Fundus photo; 45° field of view:
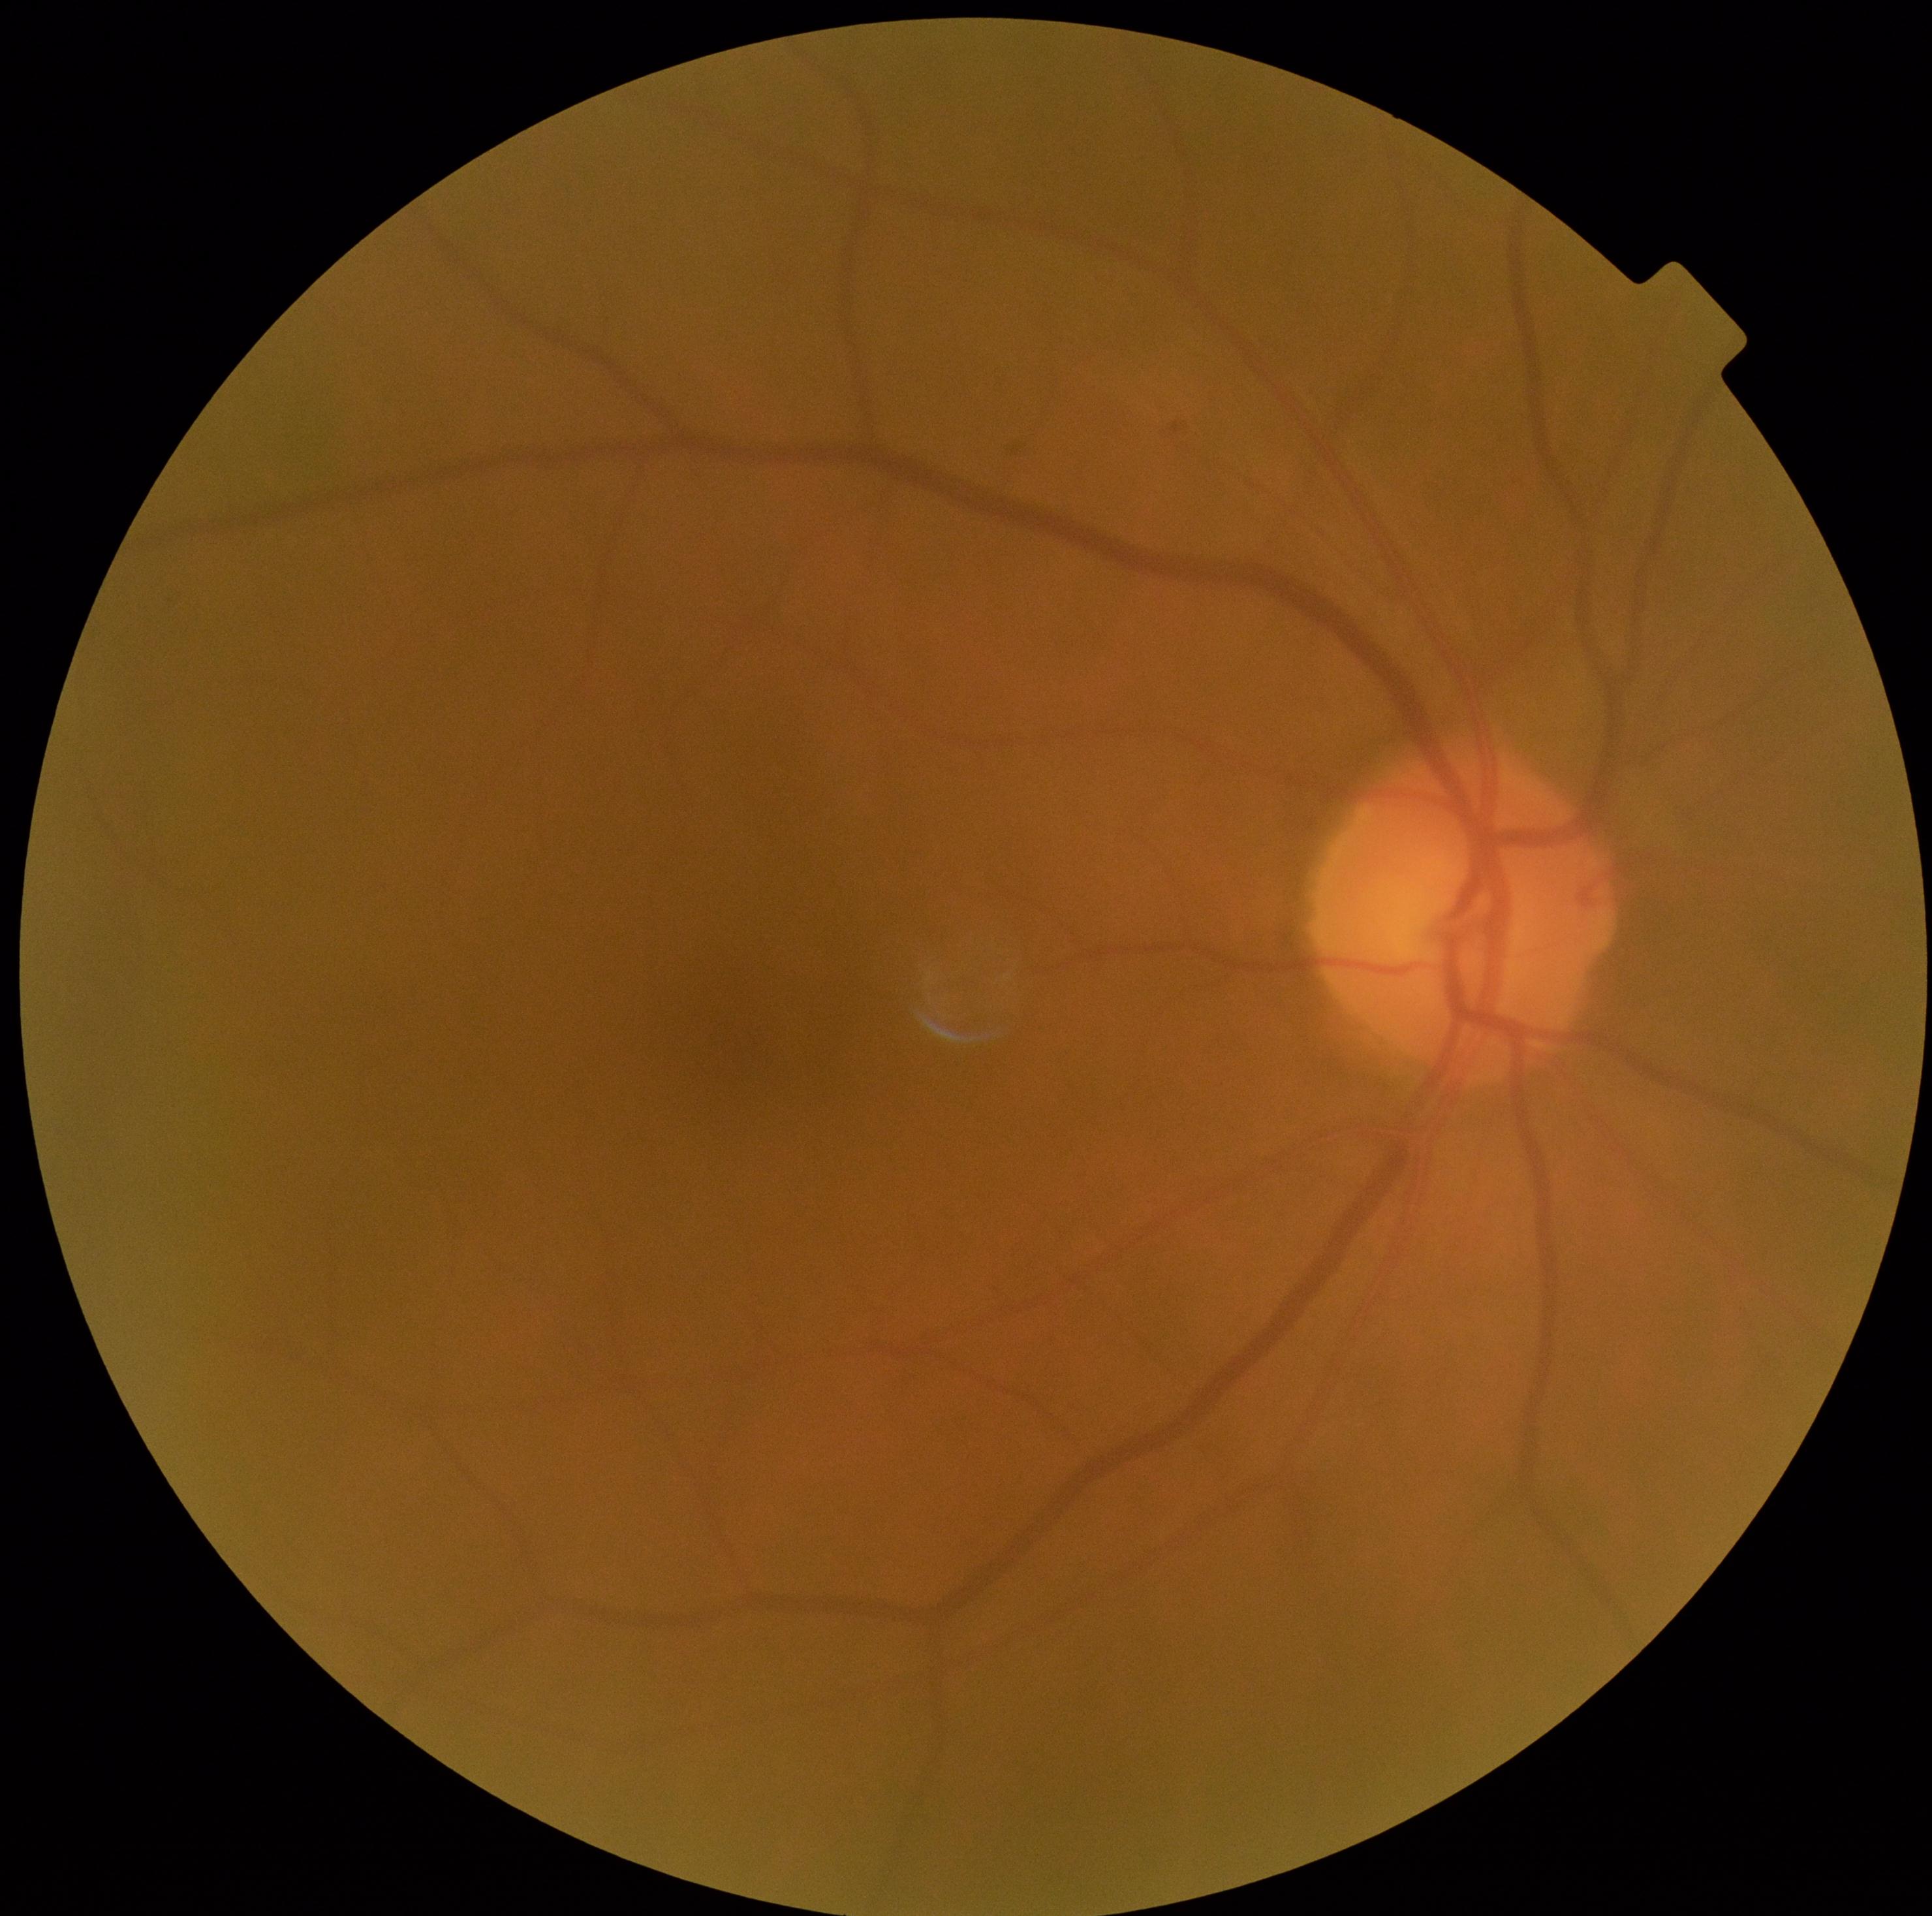
Findings:
* retinopathy: 0
* DR impression: negative for DR